2228 by 1652 pixels · mydriatic (tropicamide and phenylephrine)
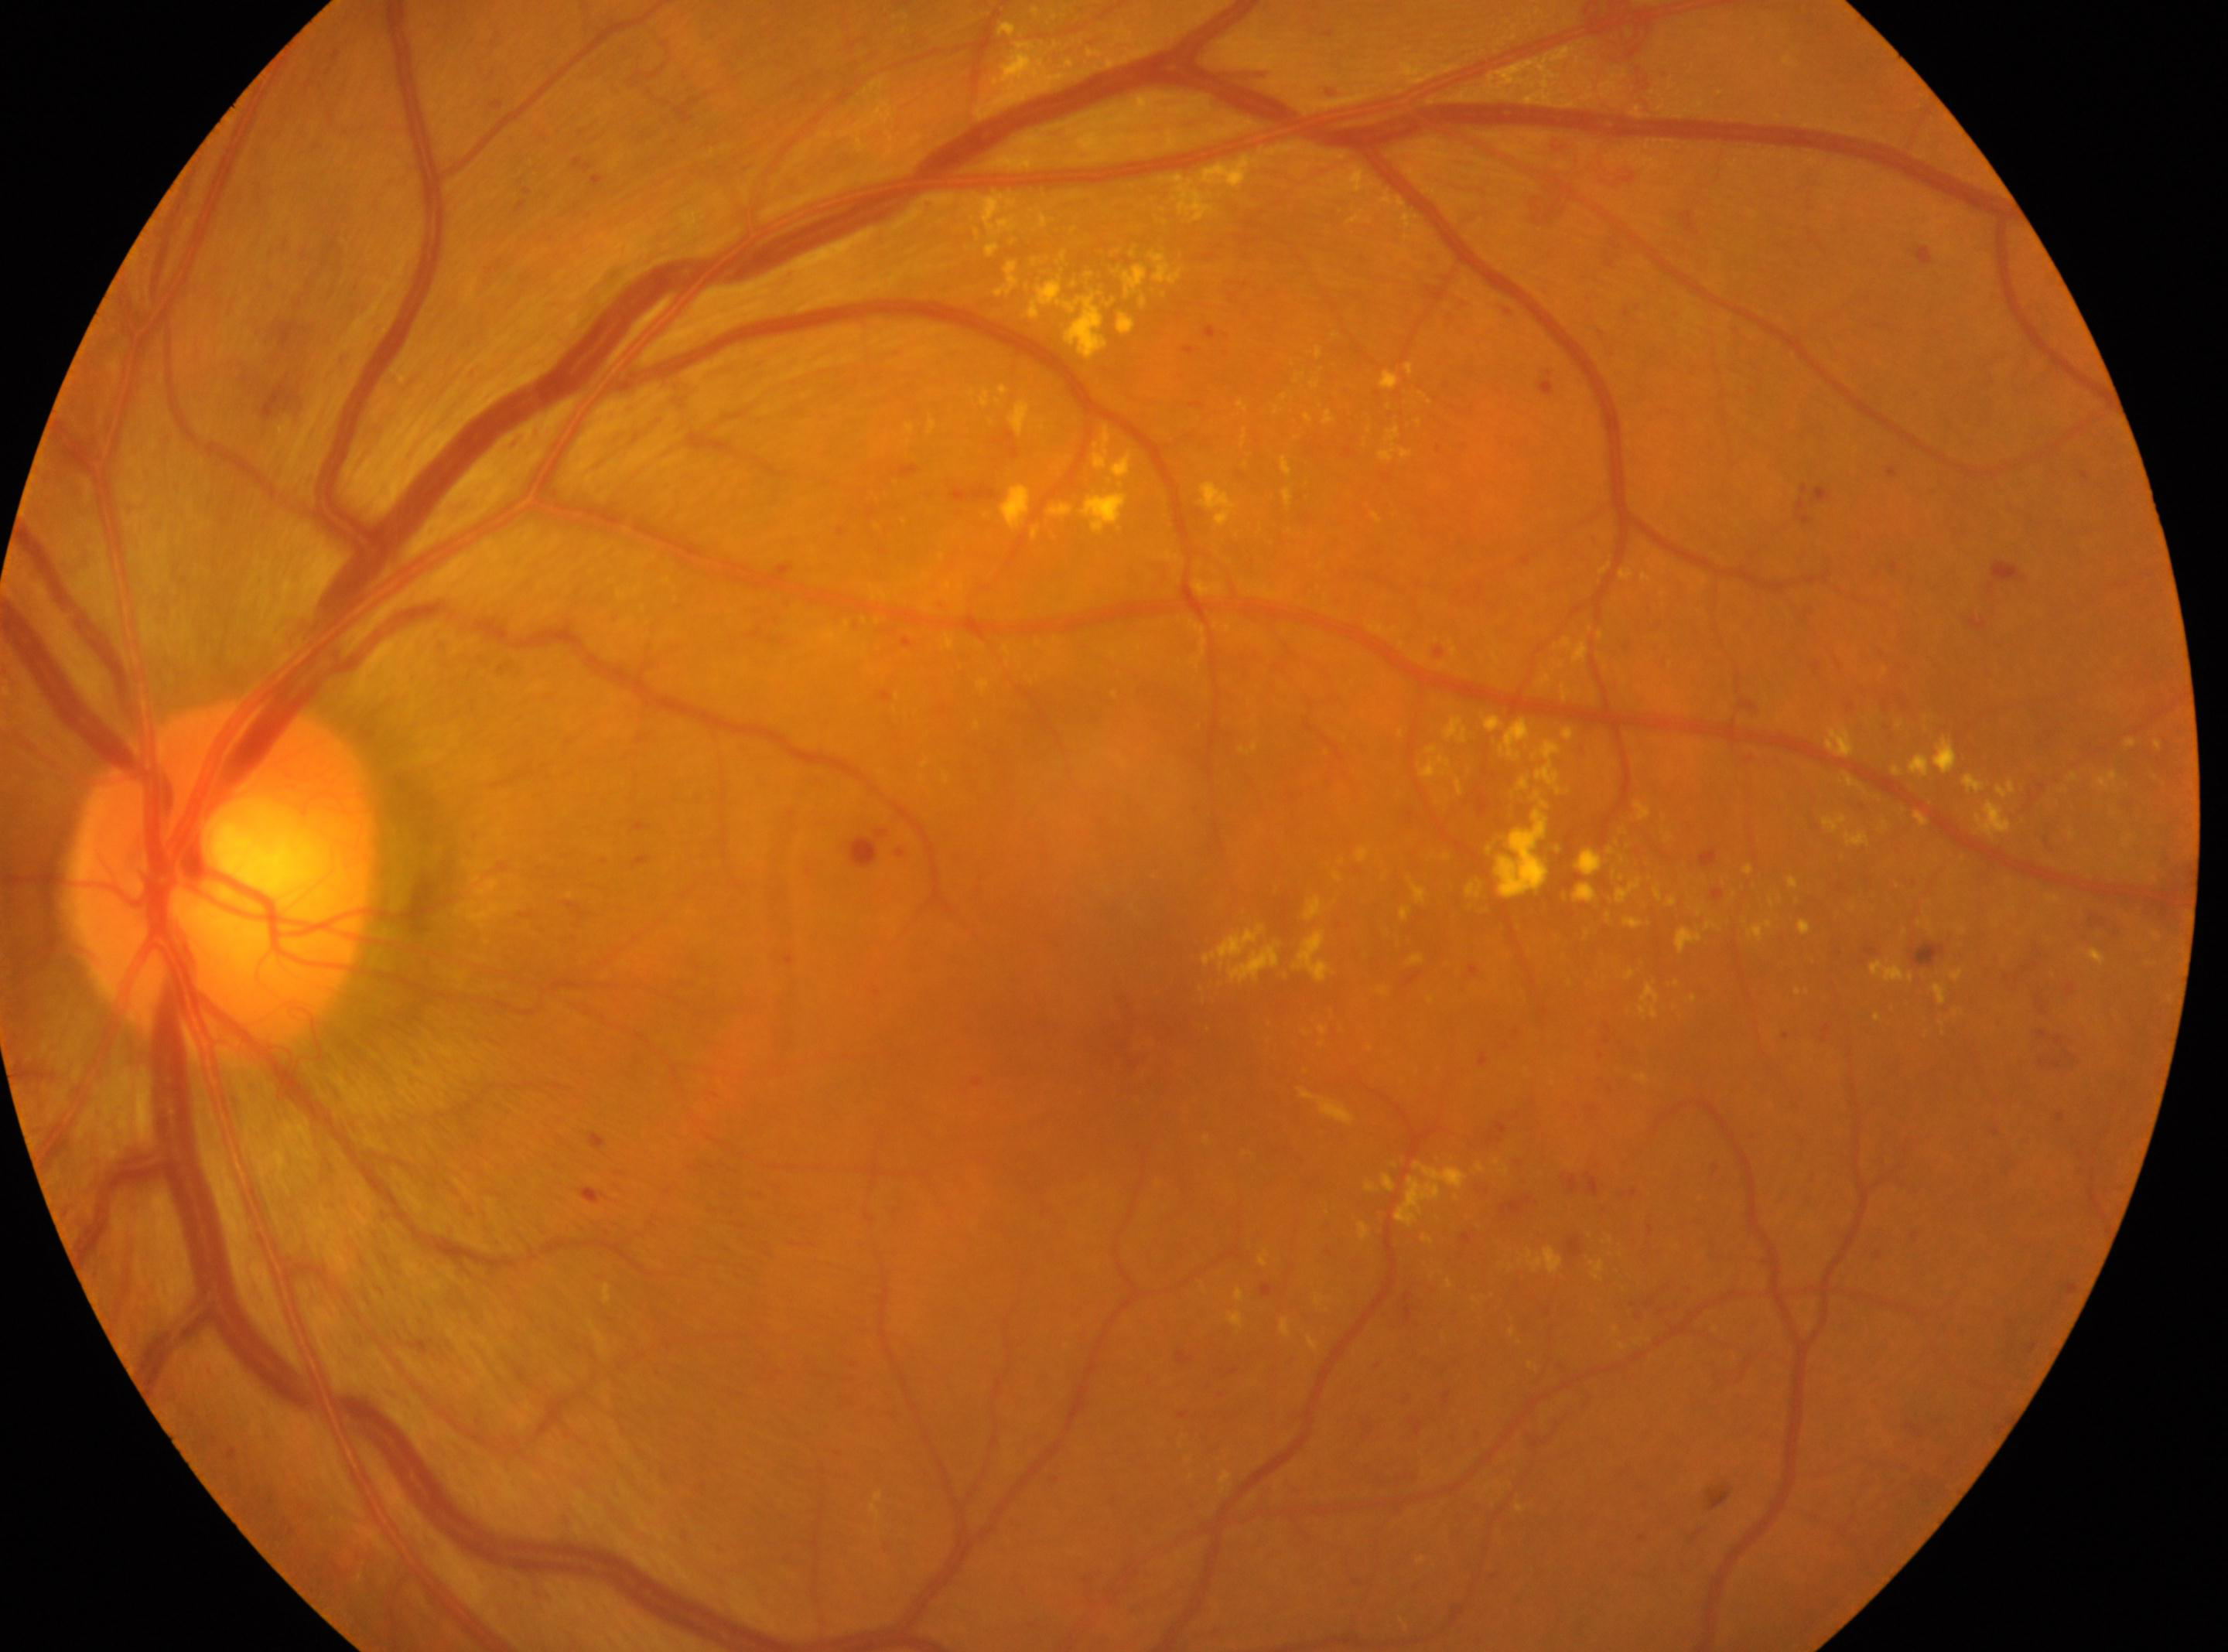 The optic nerve head is at x=223, y=875. Fovea: x=1139, y=1053. This is the OS. DR severity is 4.